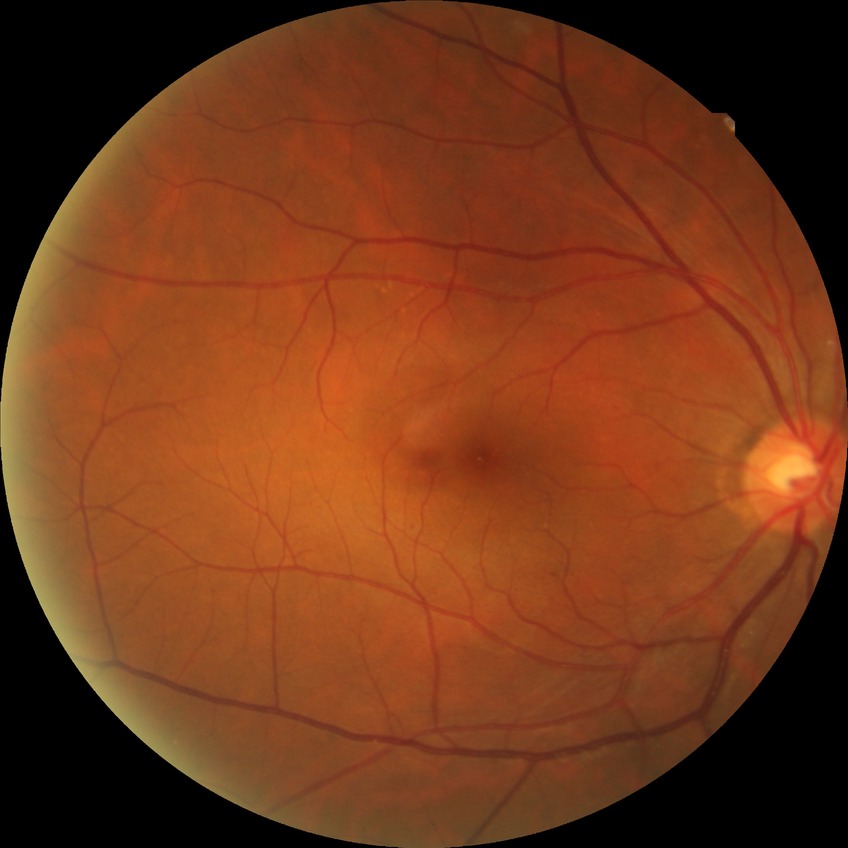 diabetic retinopathy (DR) = simple diabetic retinopathy (SDR)